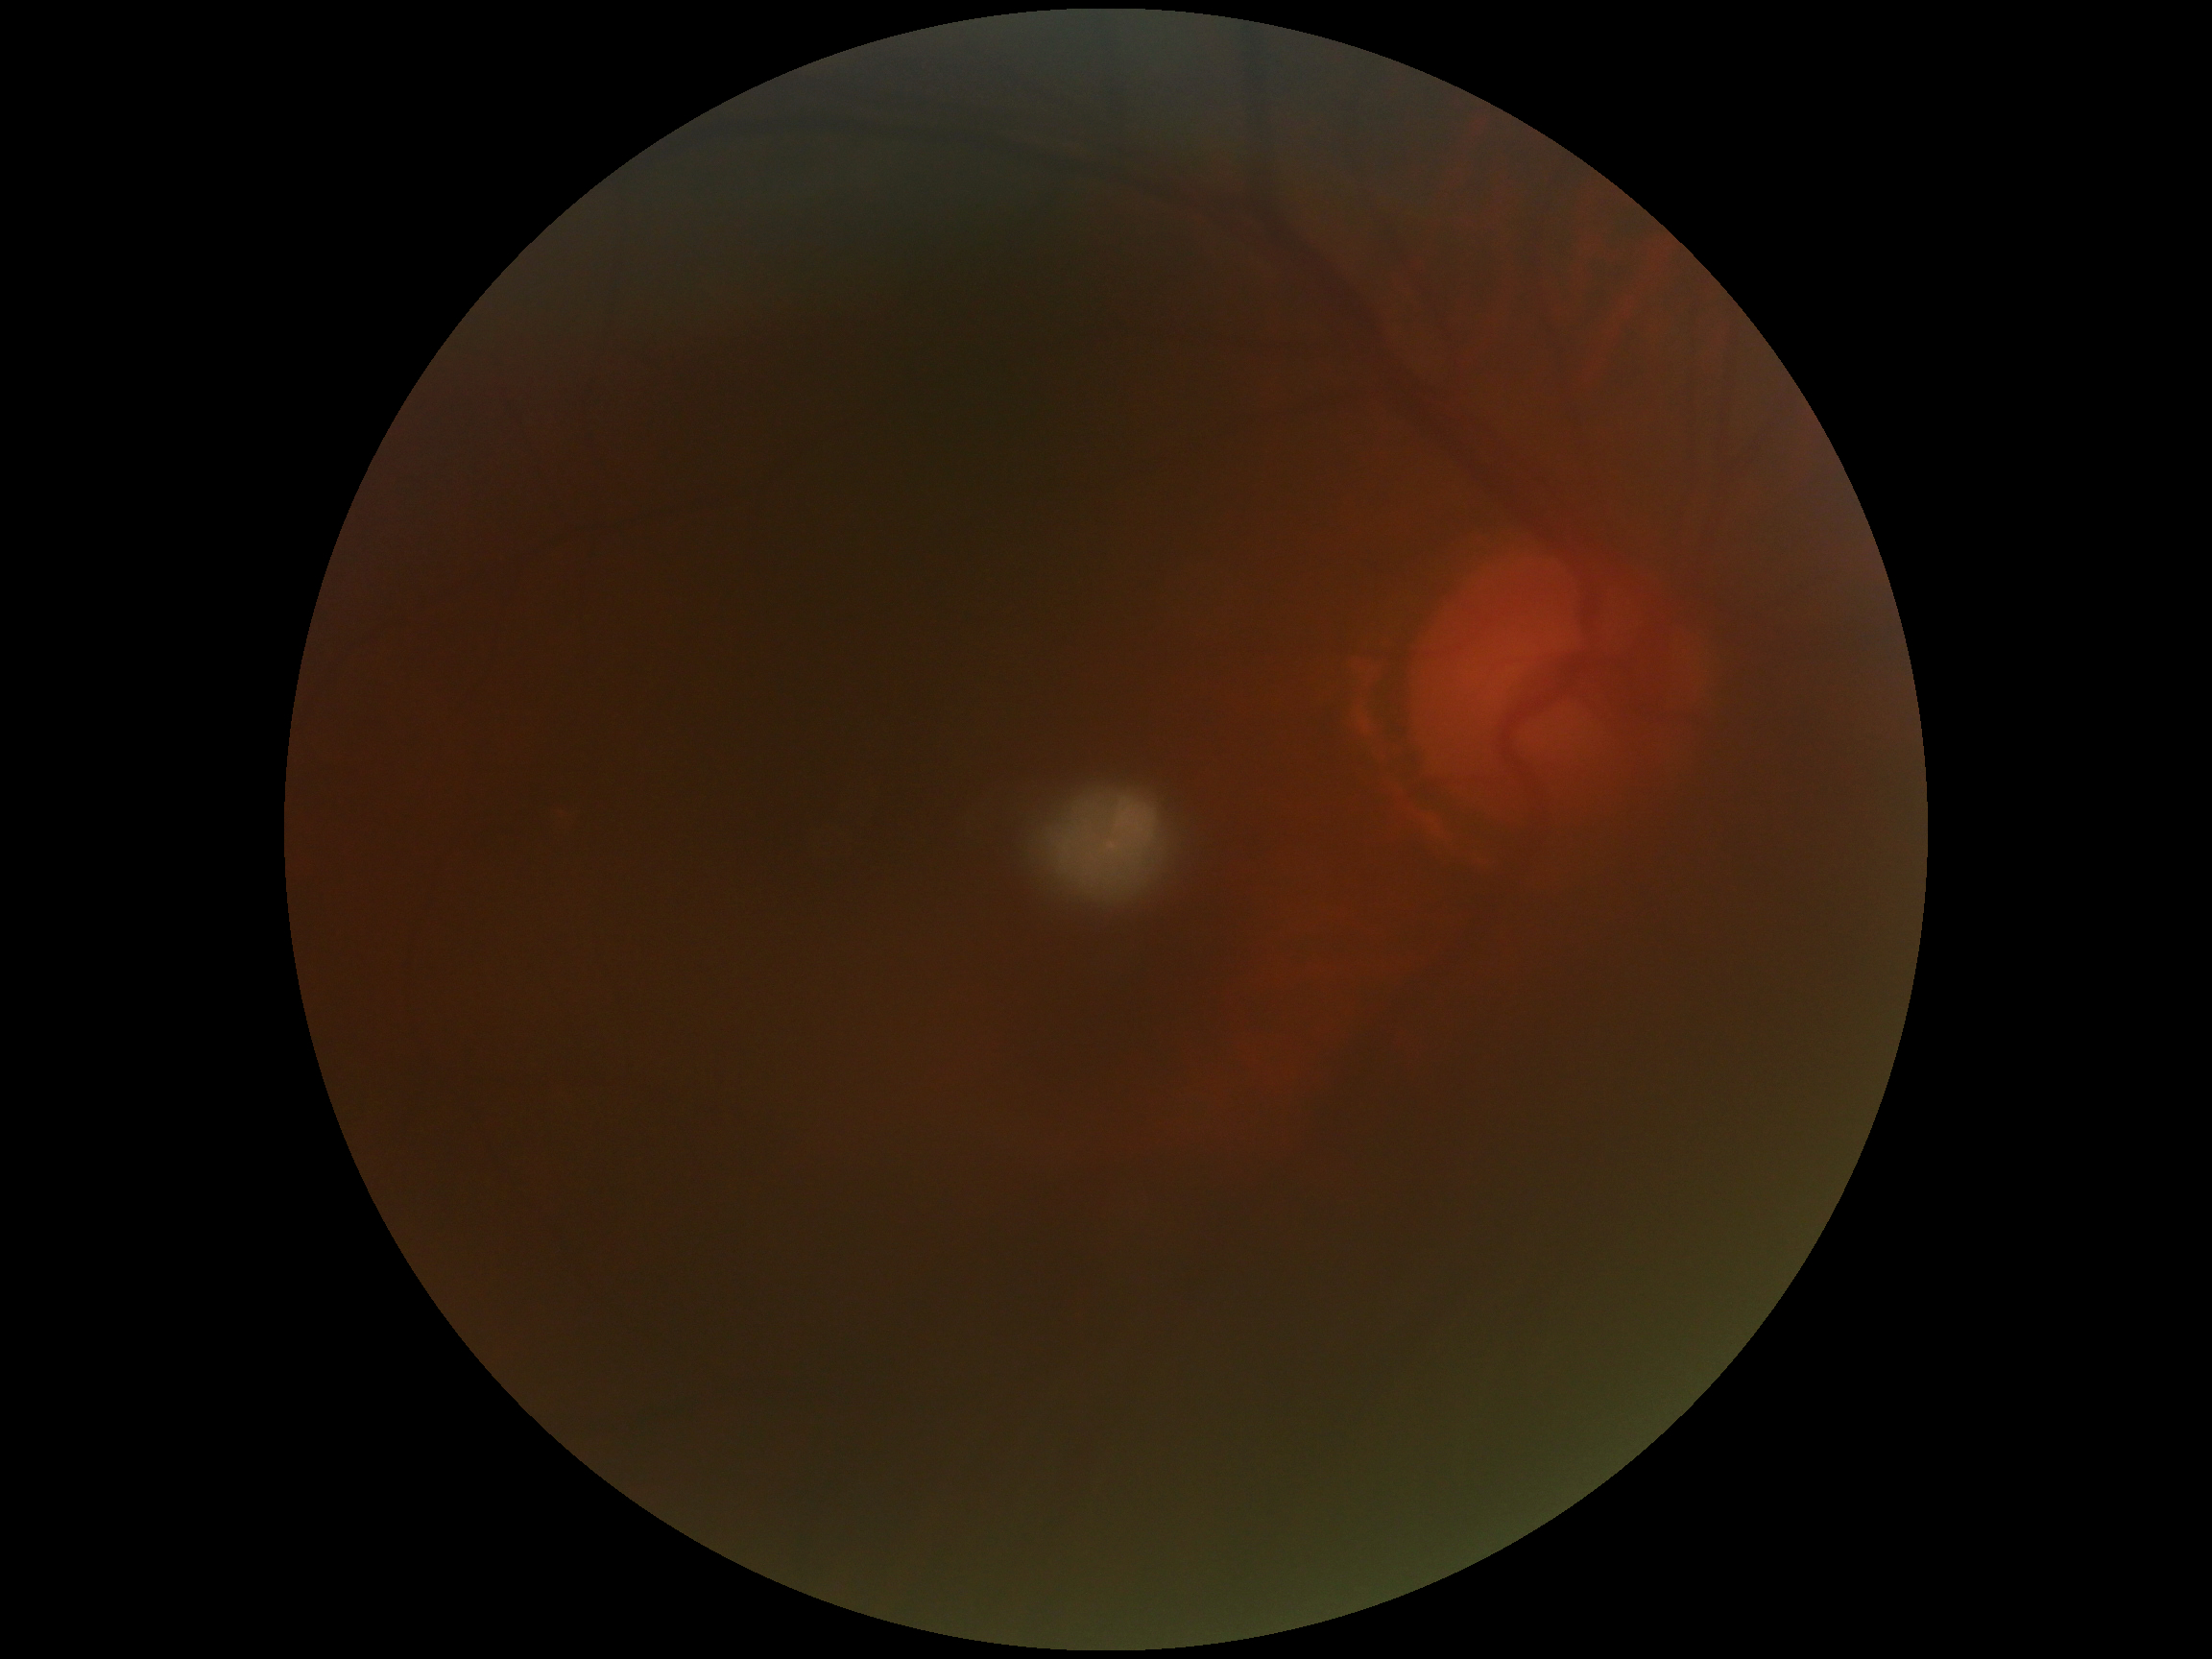
diabetic retinopathy severity@ungradable due to poor image quality, image quality@too poor for DR grading.